Fundus photo; 45° FOV.
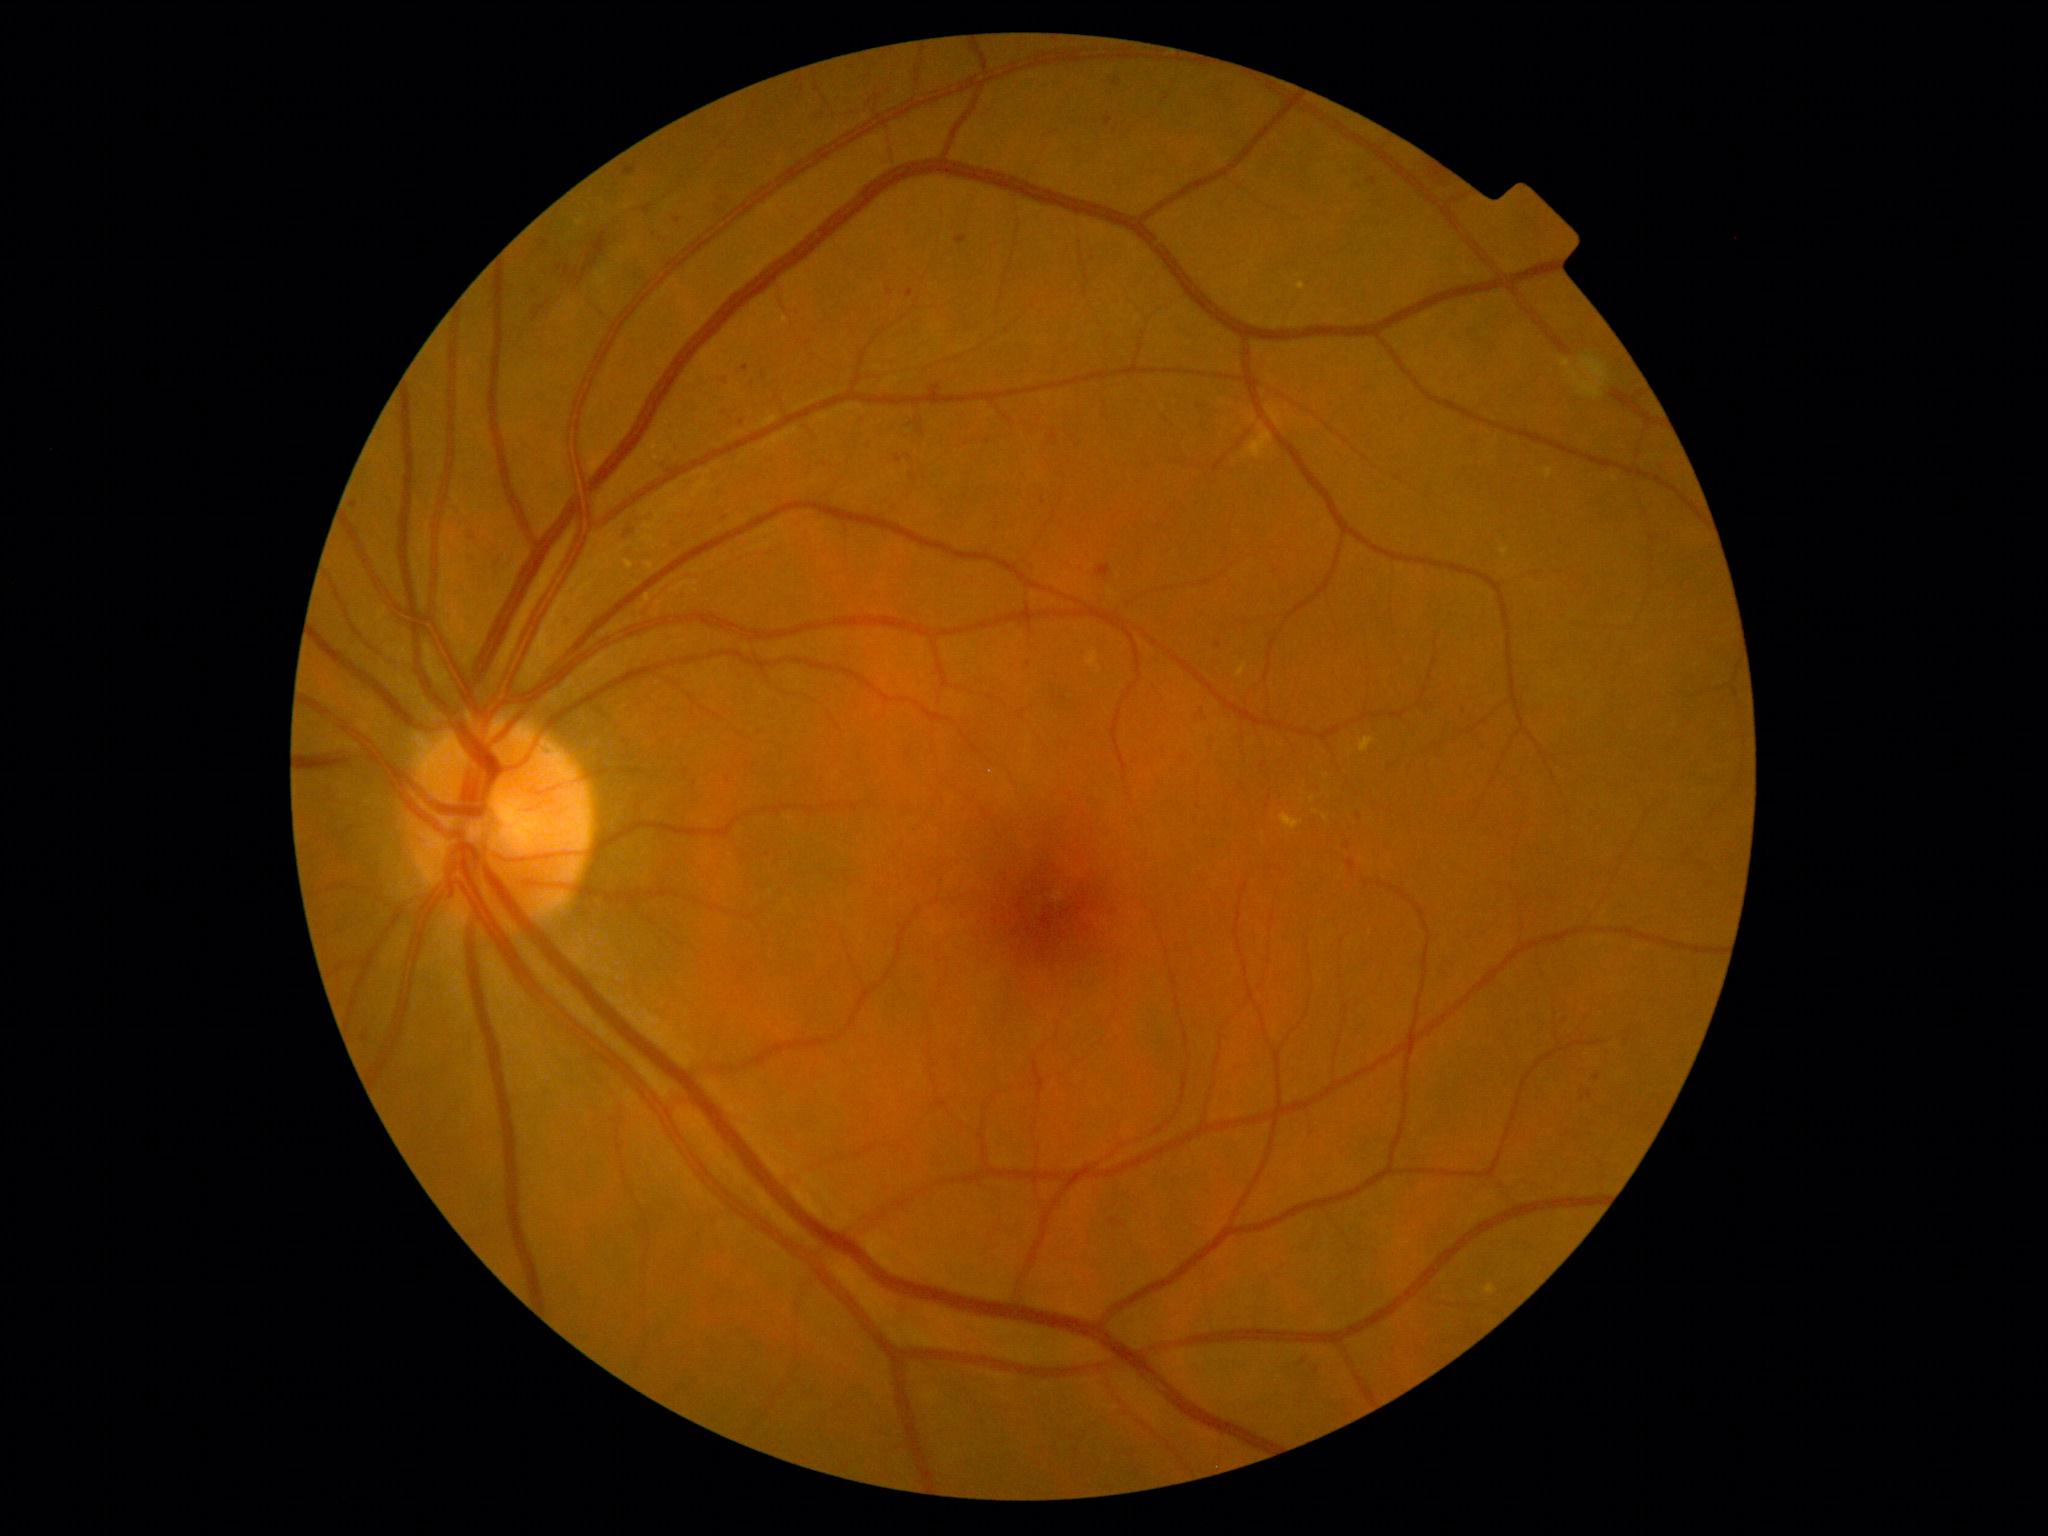
DR: grade 2 (moderate NPDR).